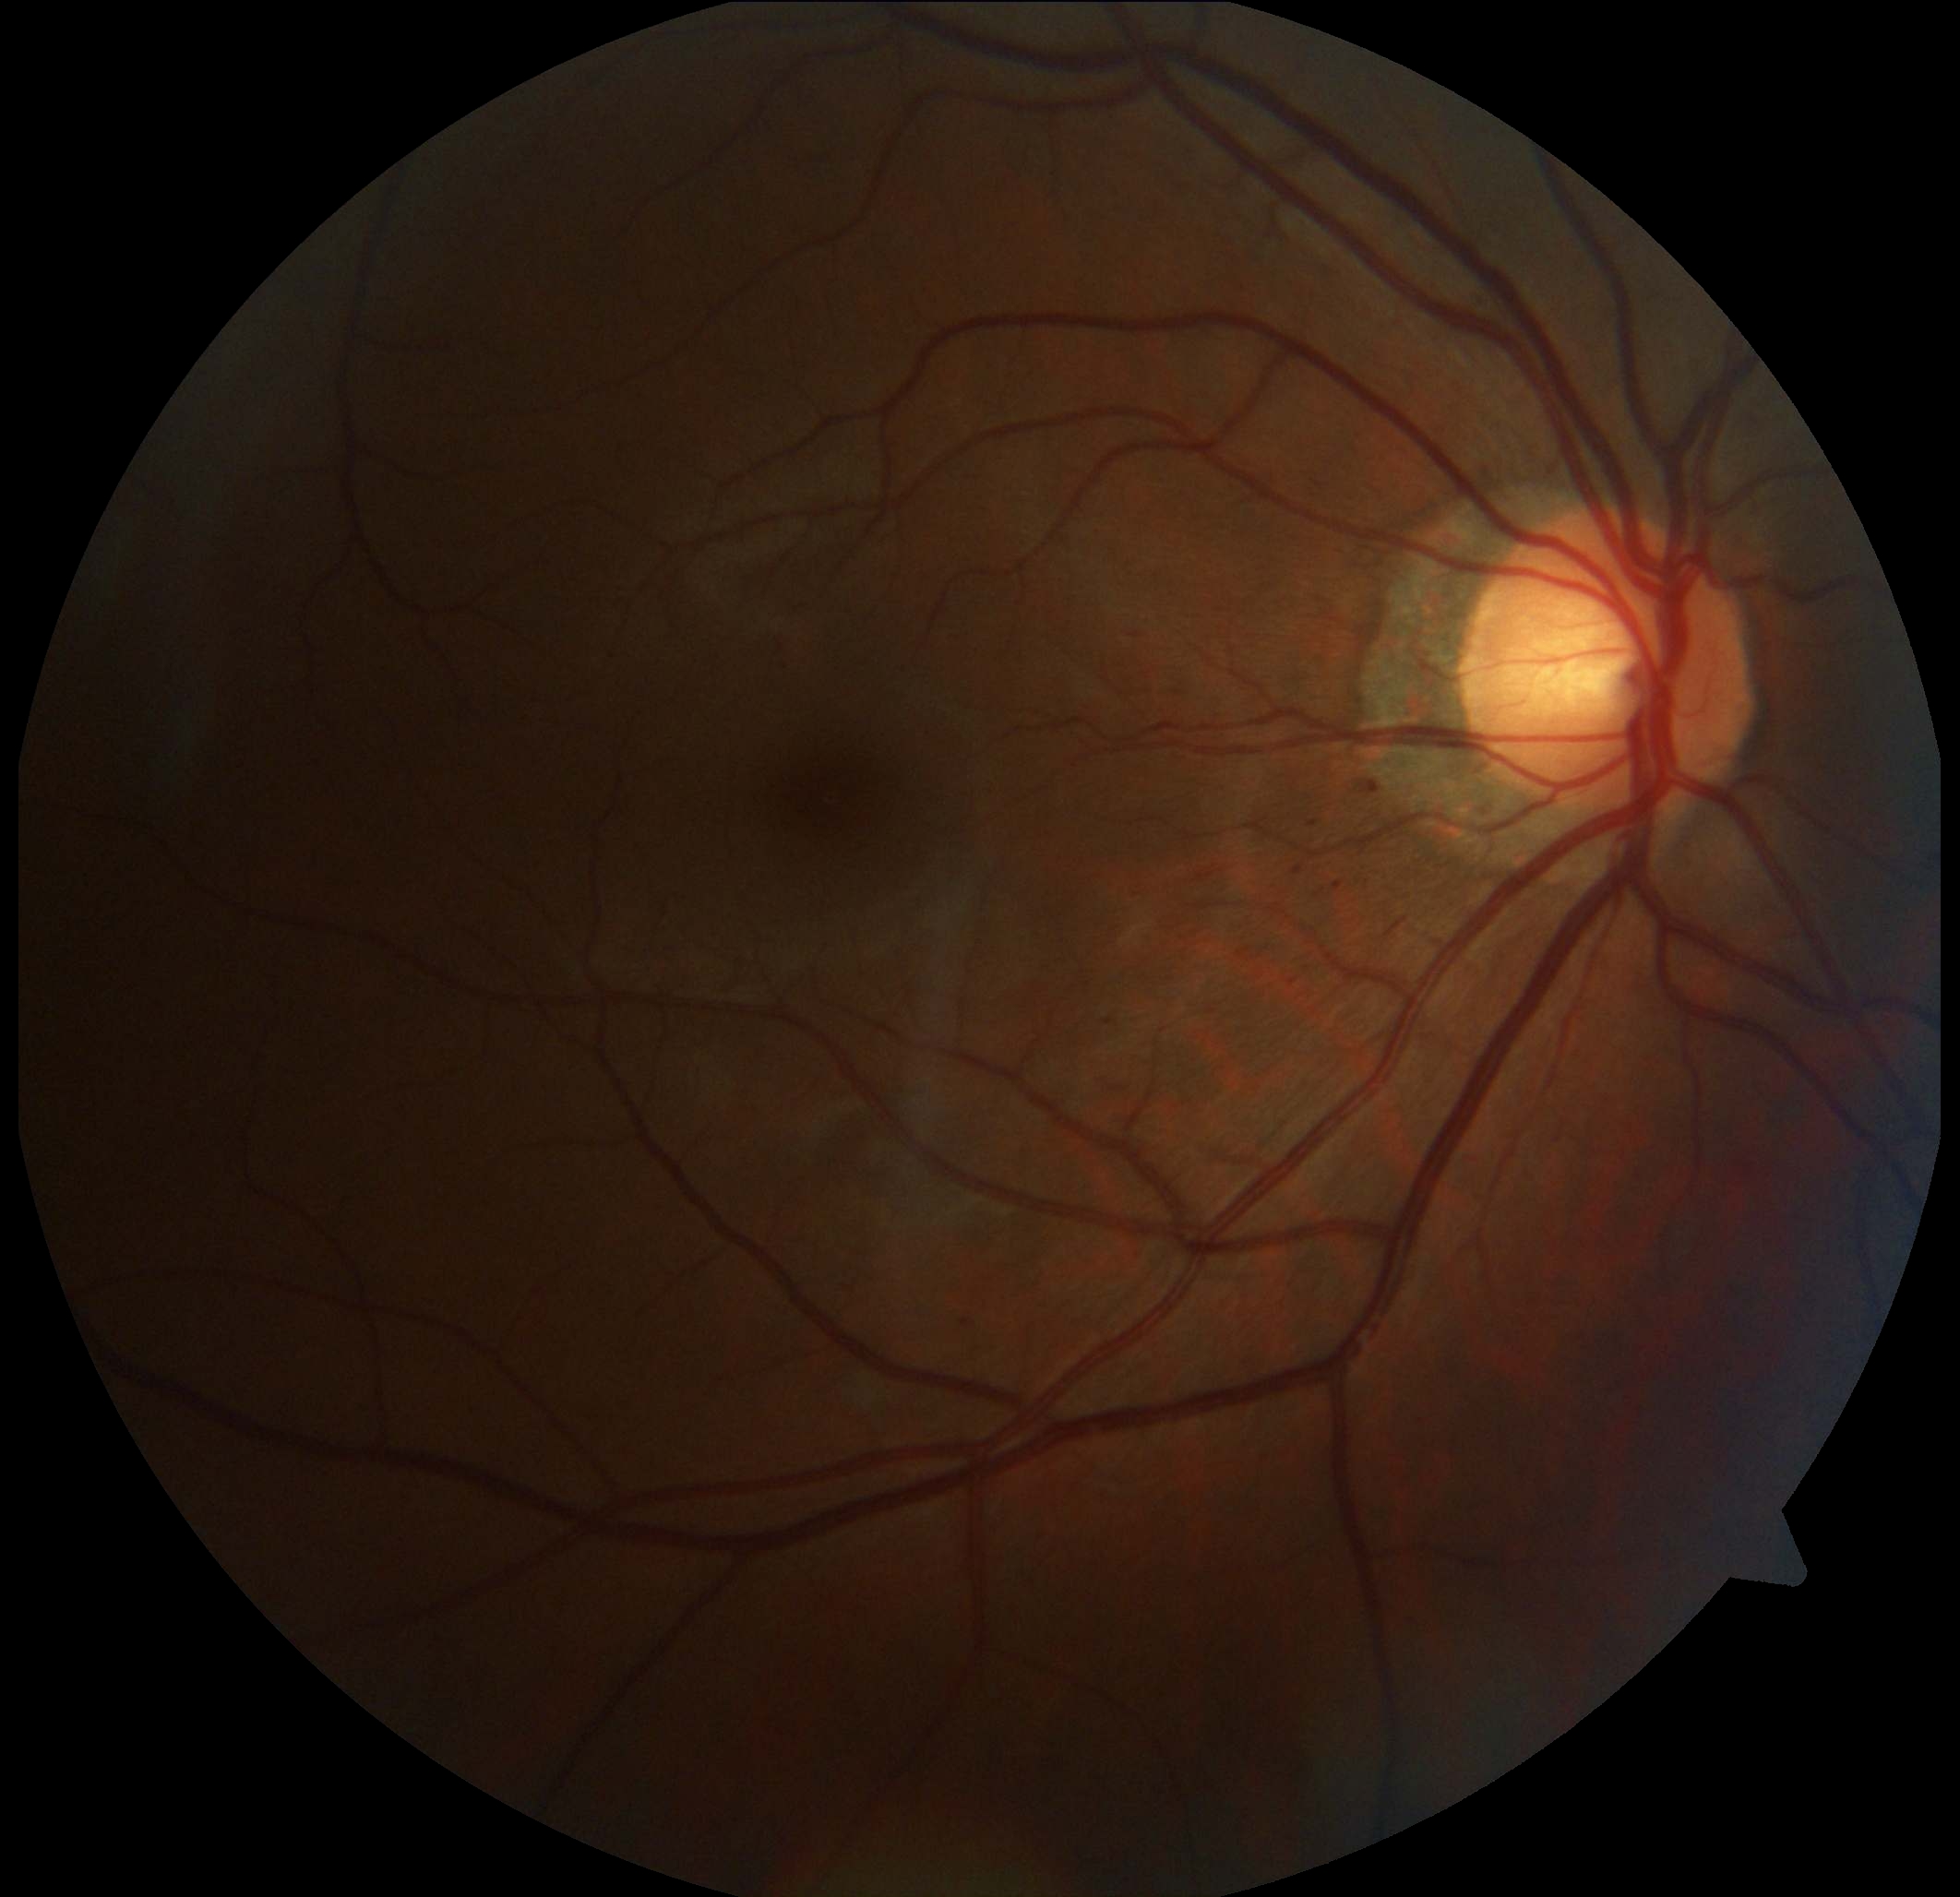
<lesions partial="true">
  <dr_grade>1</dr_grade>
  <he />
  <se />
  <ma partial="true">bbox=[1363, 775, 1386, 793]; bbox=[782, 655, 785, 668]; bbox=[1329, 878, 1344, 887]; bbox=[1293, 867, 1304, 875]; bbox=[1105, 1020, 1115, 1026]; bbox=[1309, 819, 1321, 829]; bbox=[962, 1318, 974, 1328]</ma>
  <ex />
</lesions>